FOV: 45 degrees:
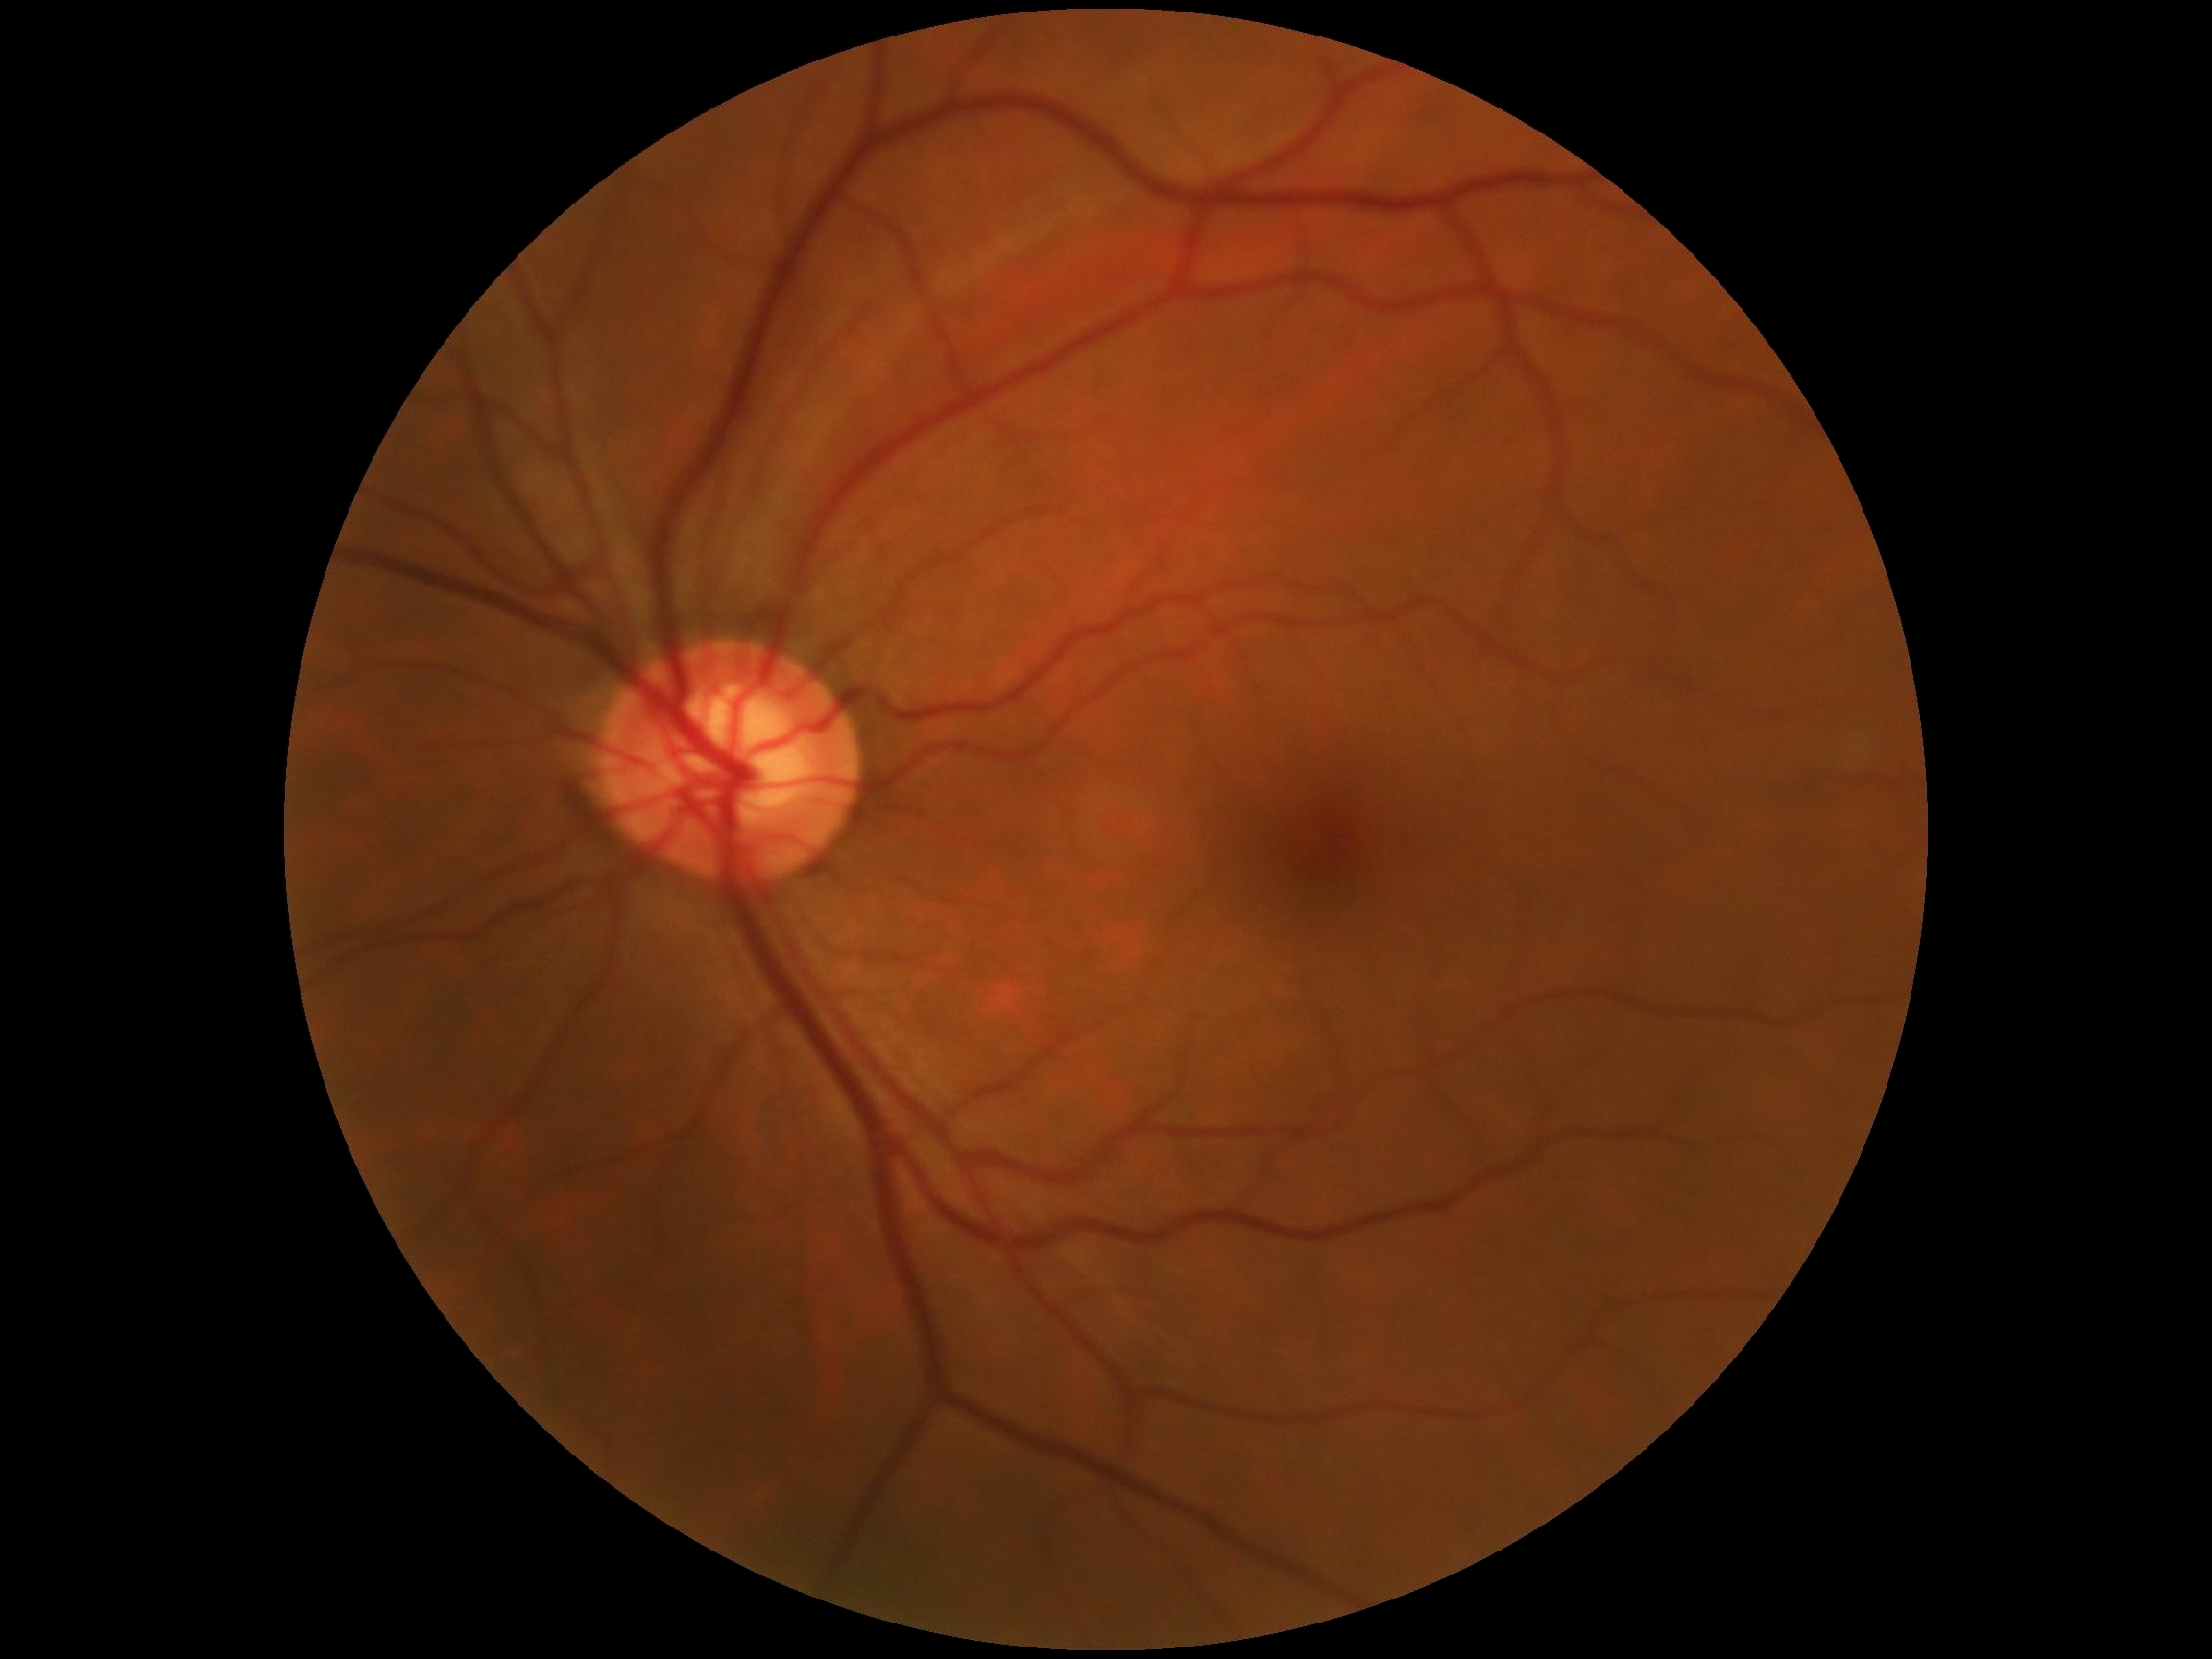
No diabetic retinal disease findings.
DR stage: grade 0 (no apparent retinopathy).